CFP
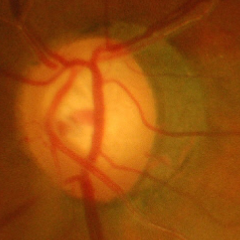

Q: Is glaucoma present?
A: Yes — advanced-stage glaucoma.